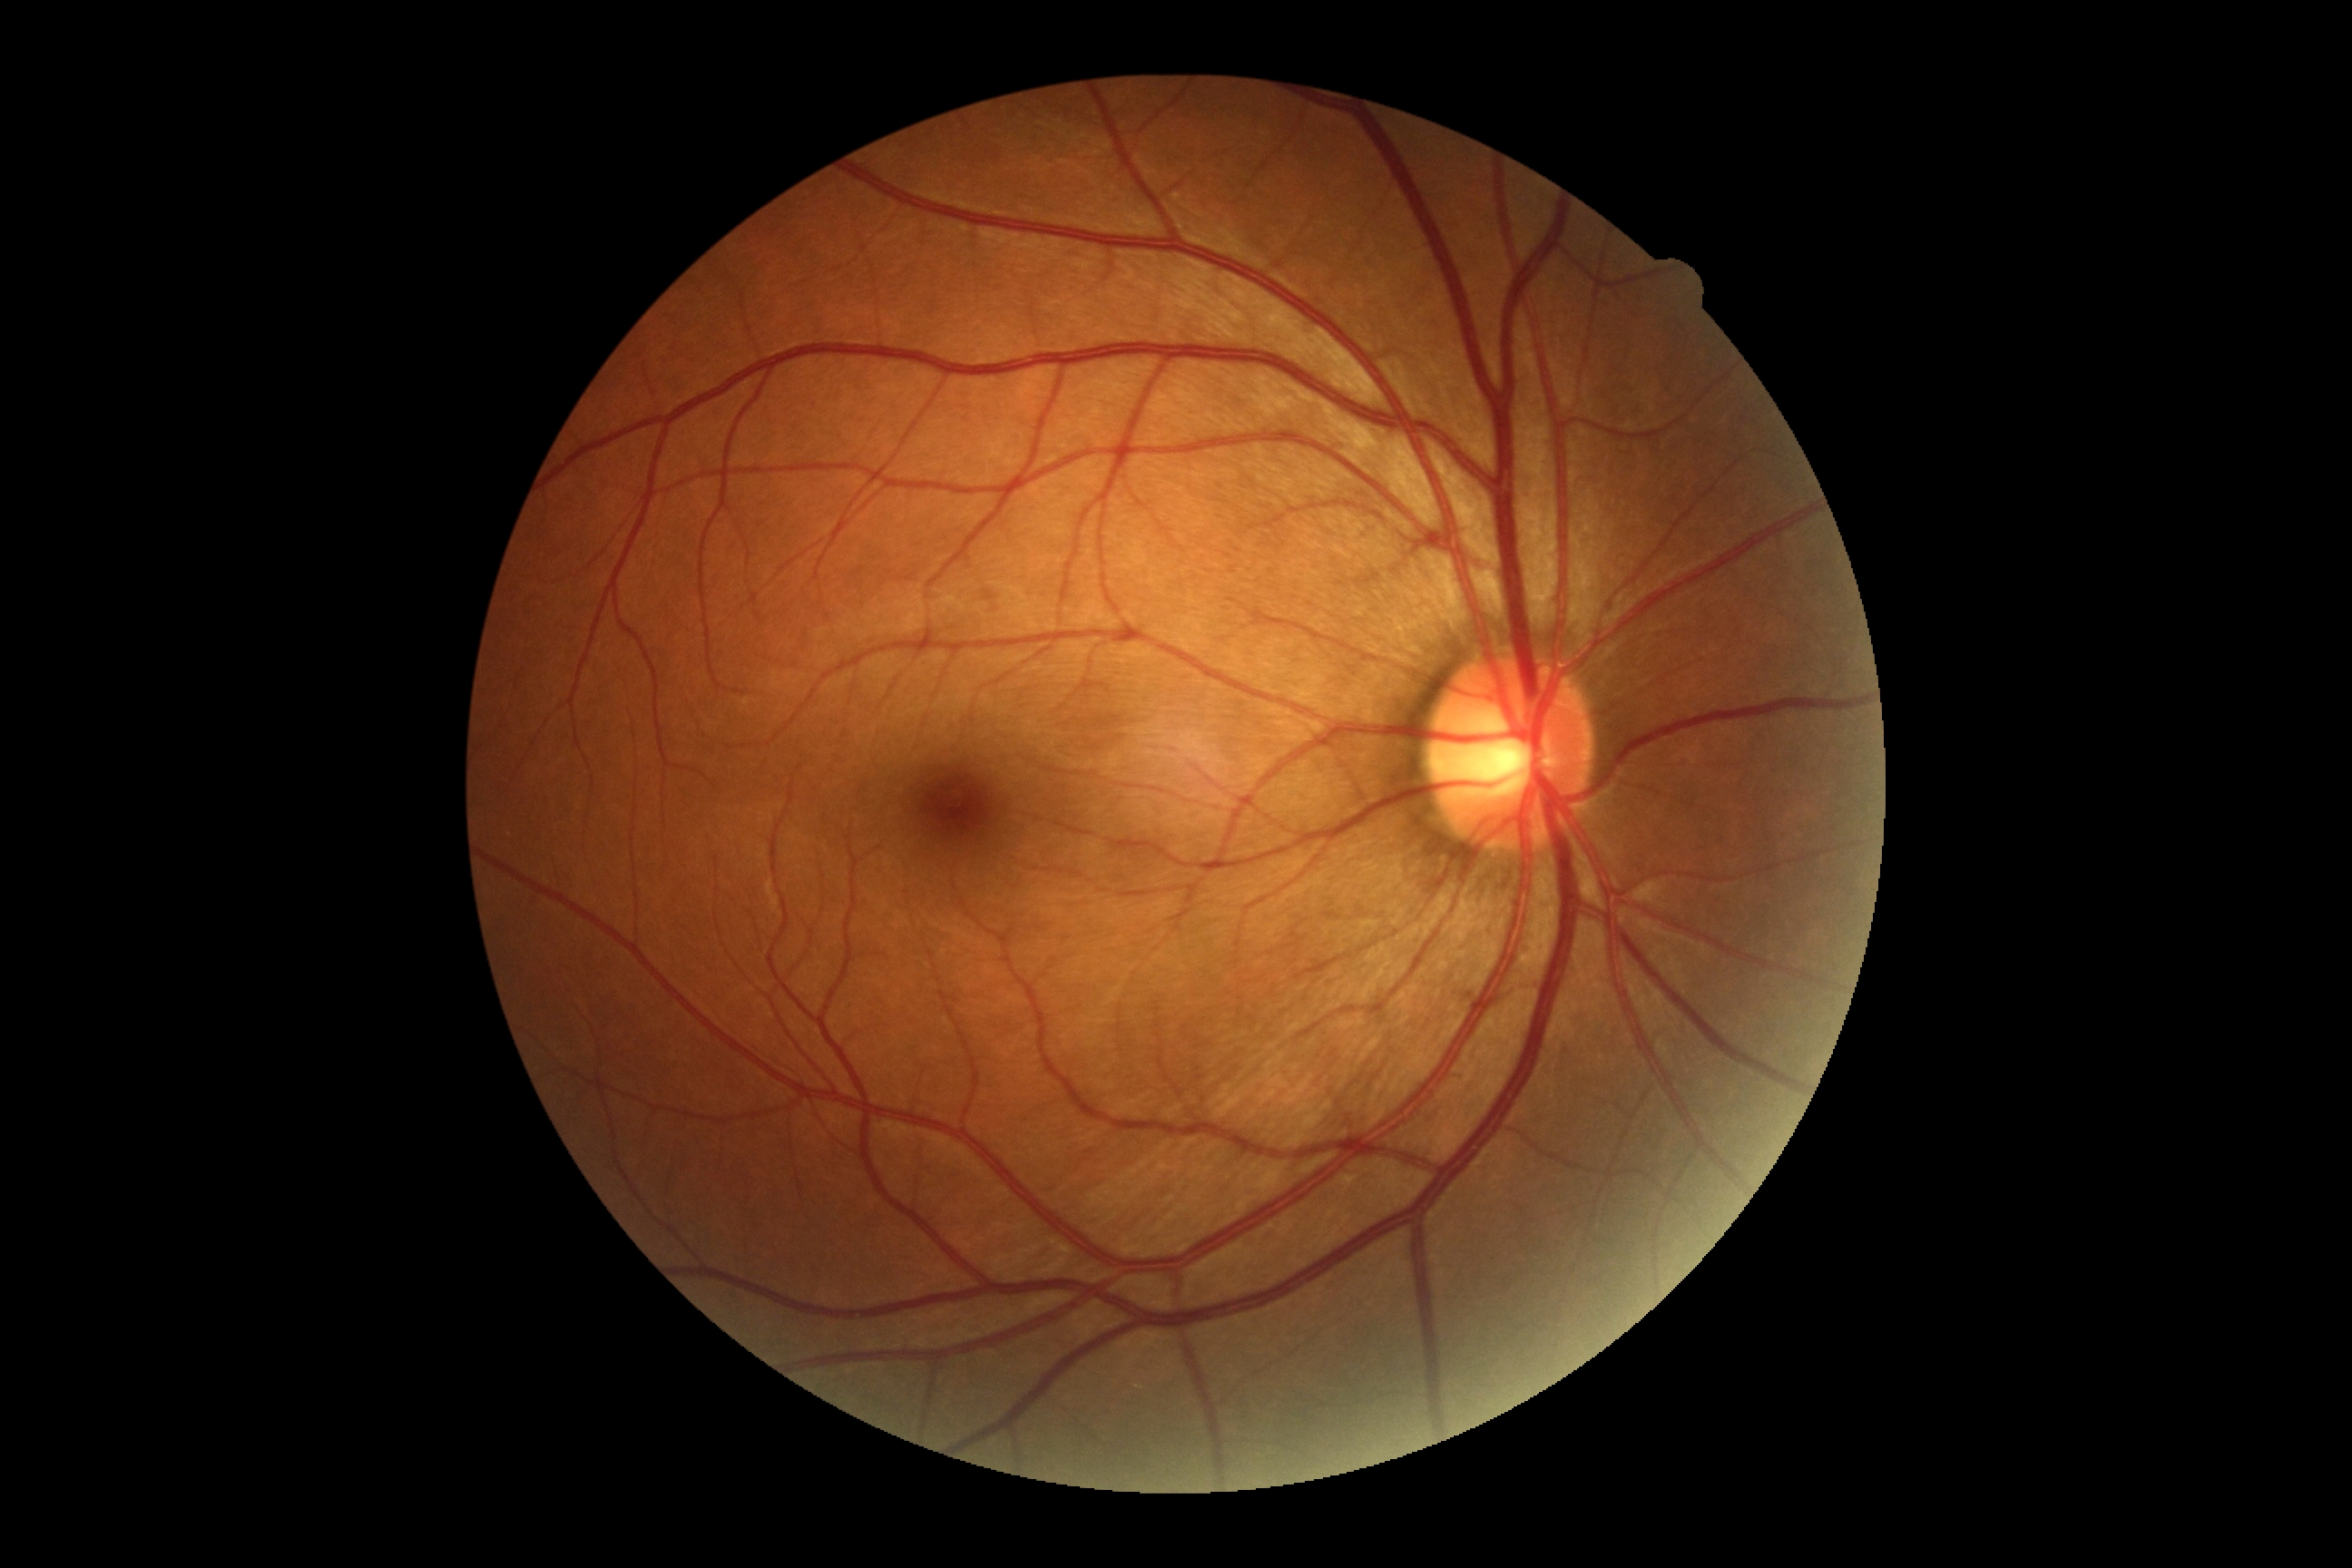

Findings:
- DR stage — 0/4